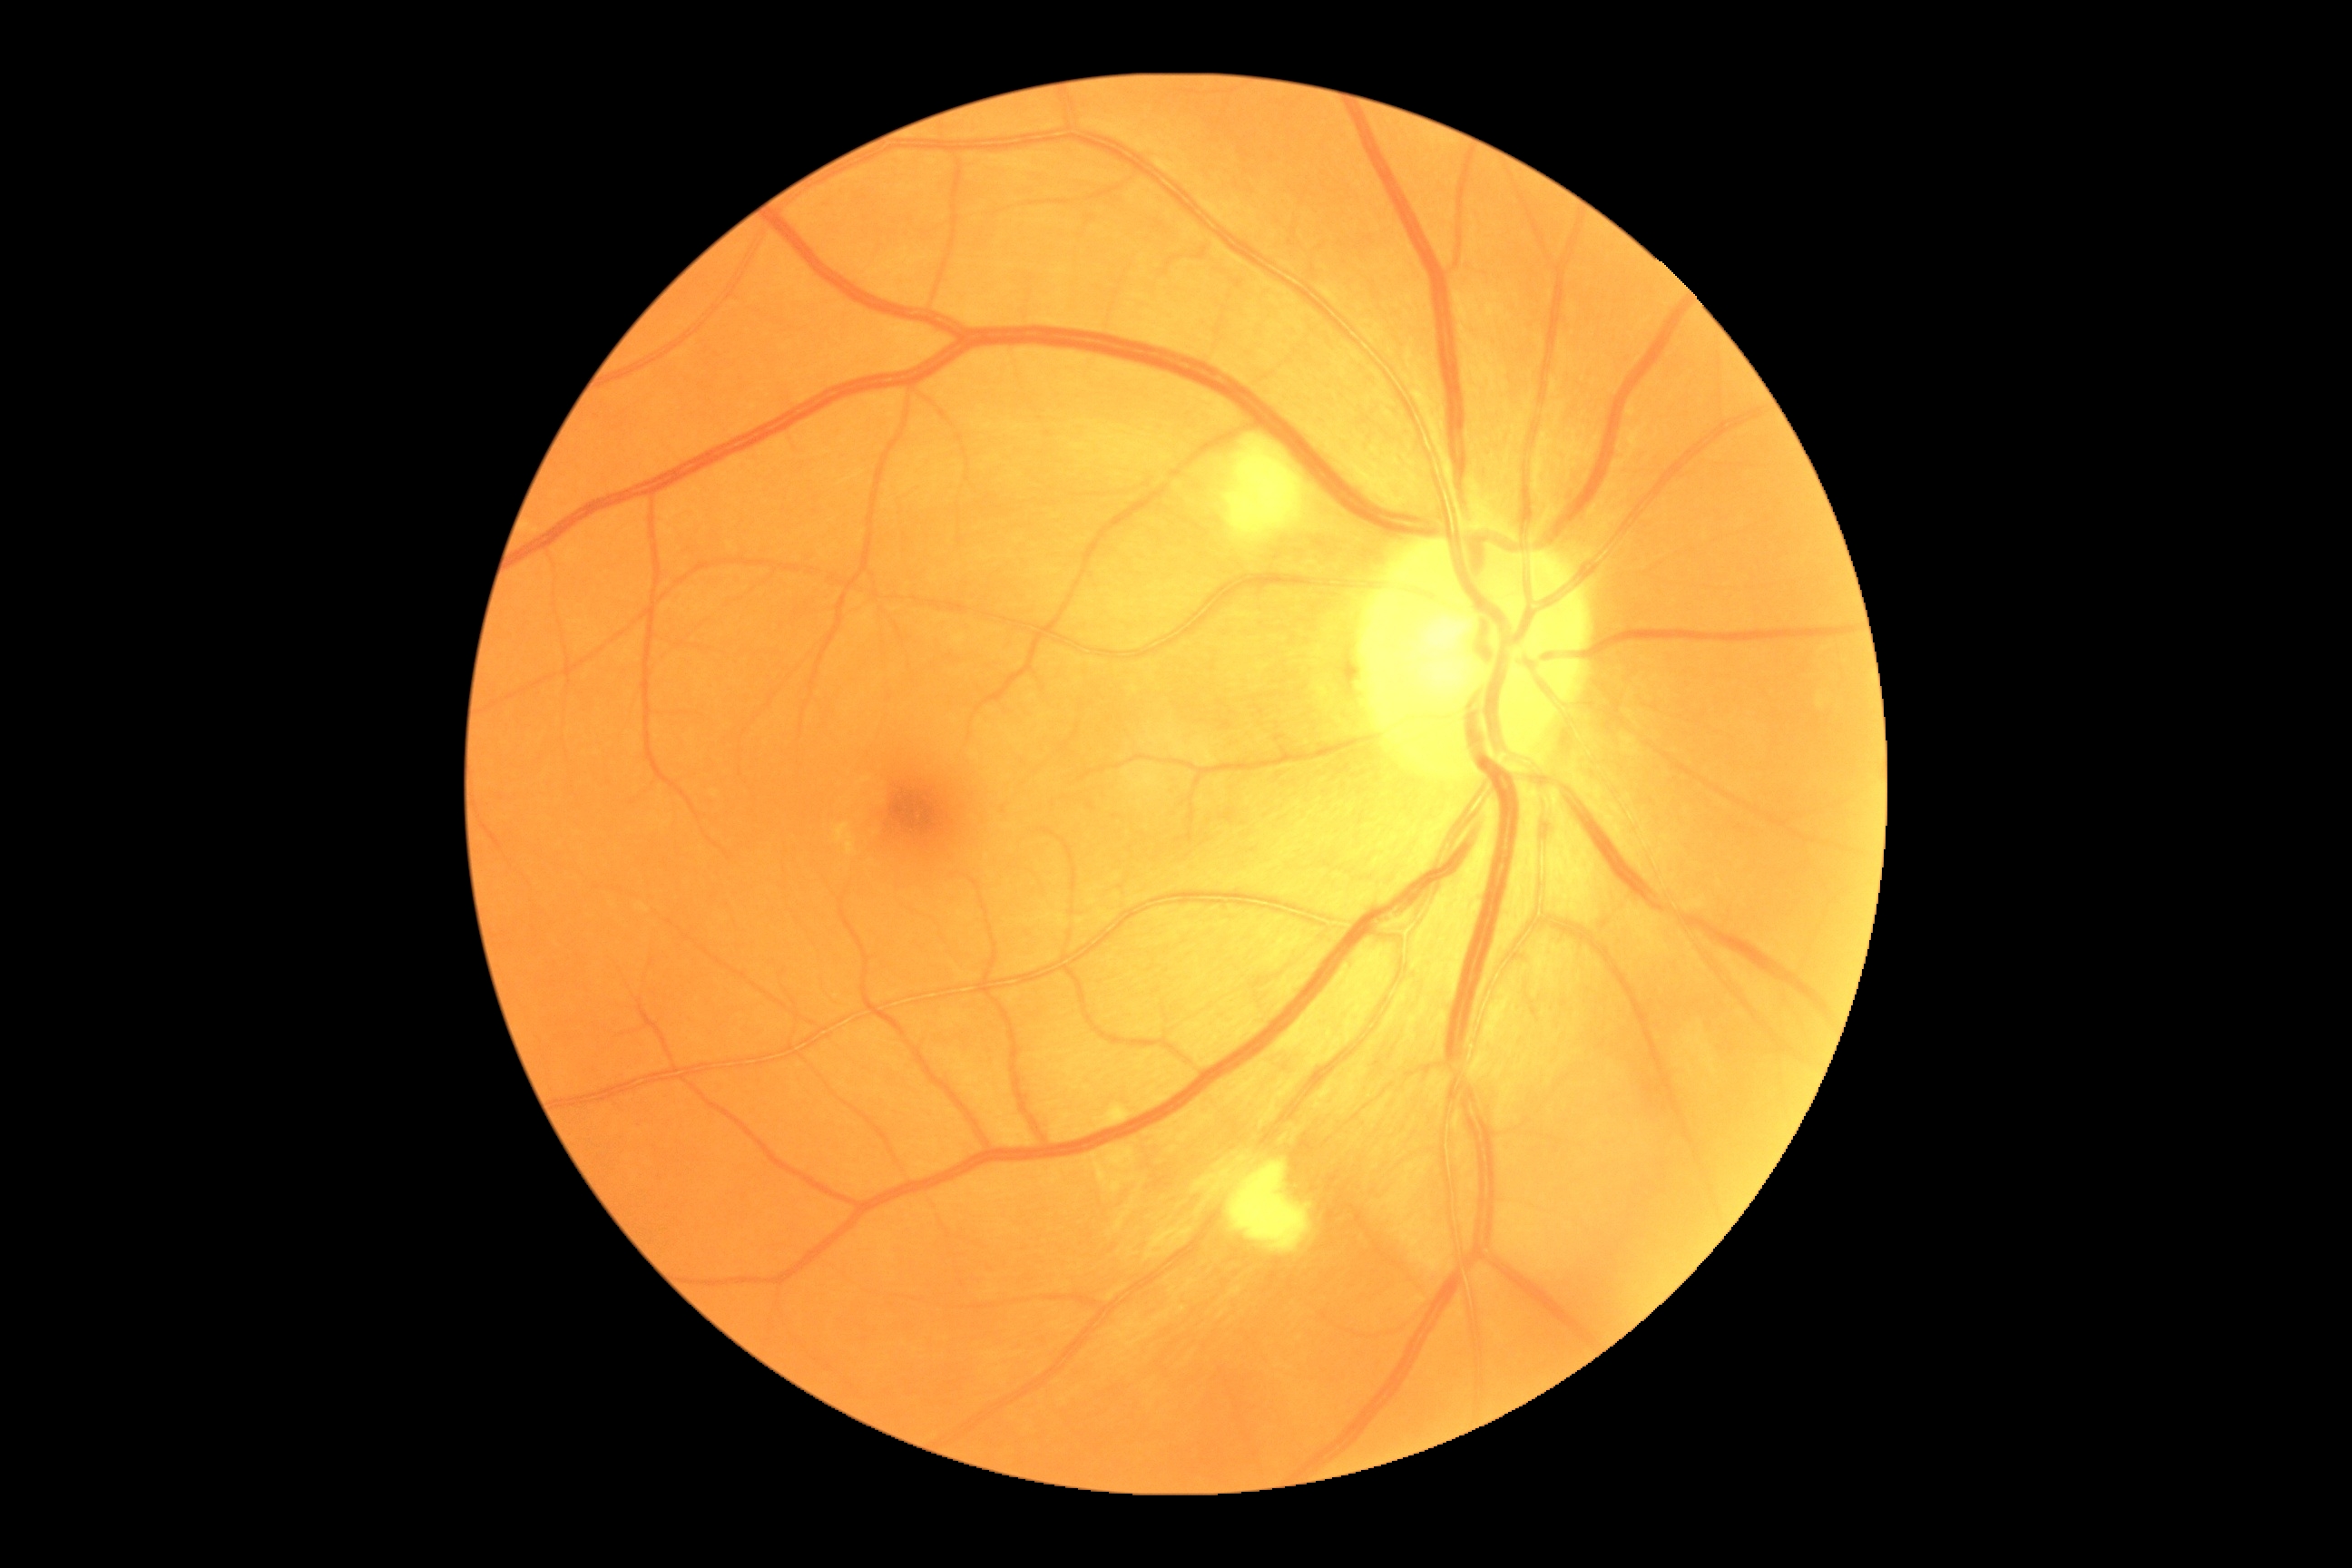 DR class: non-proliferative diabetic retinopathy. Retinopathy: grade 2 (moderate NPDR).